Retinal fundus photograph. FOV: 45 degrees:
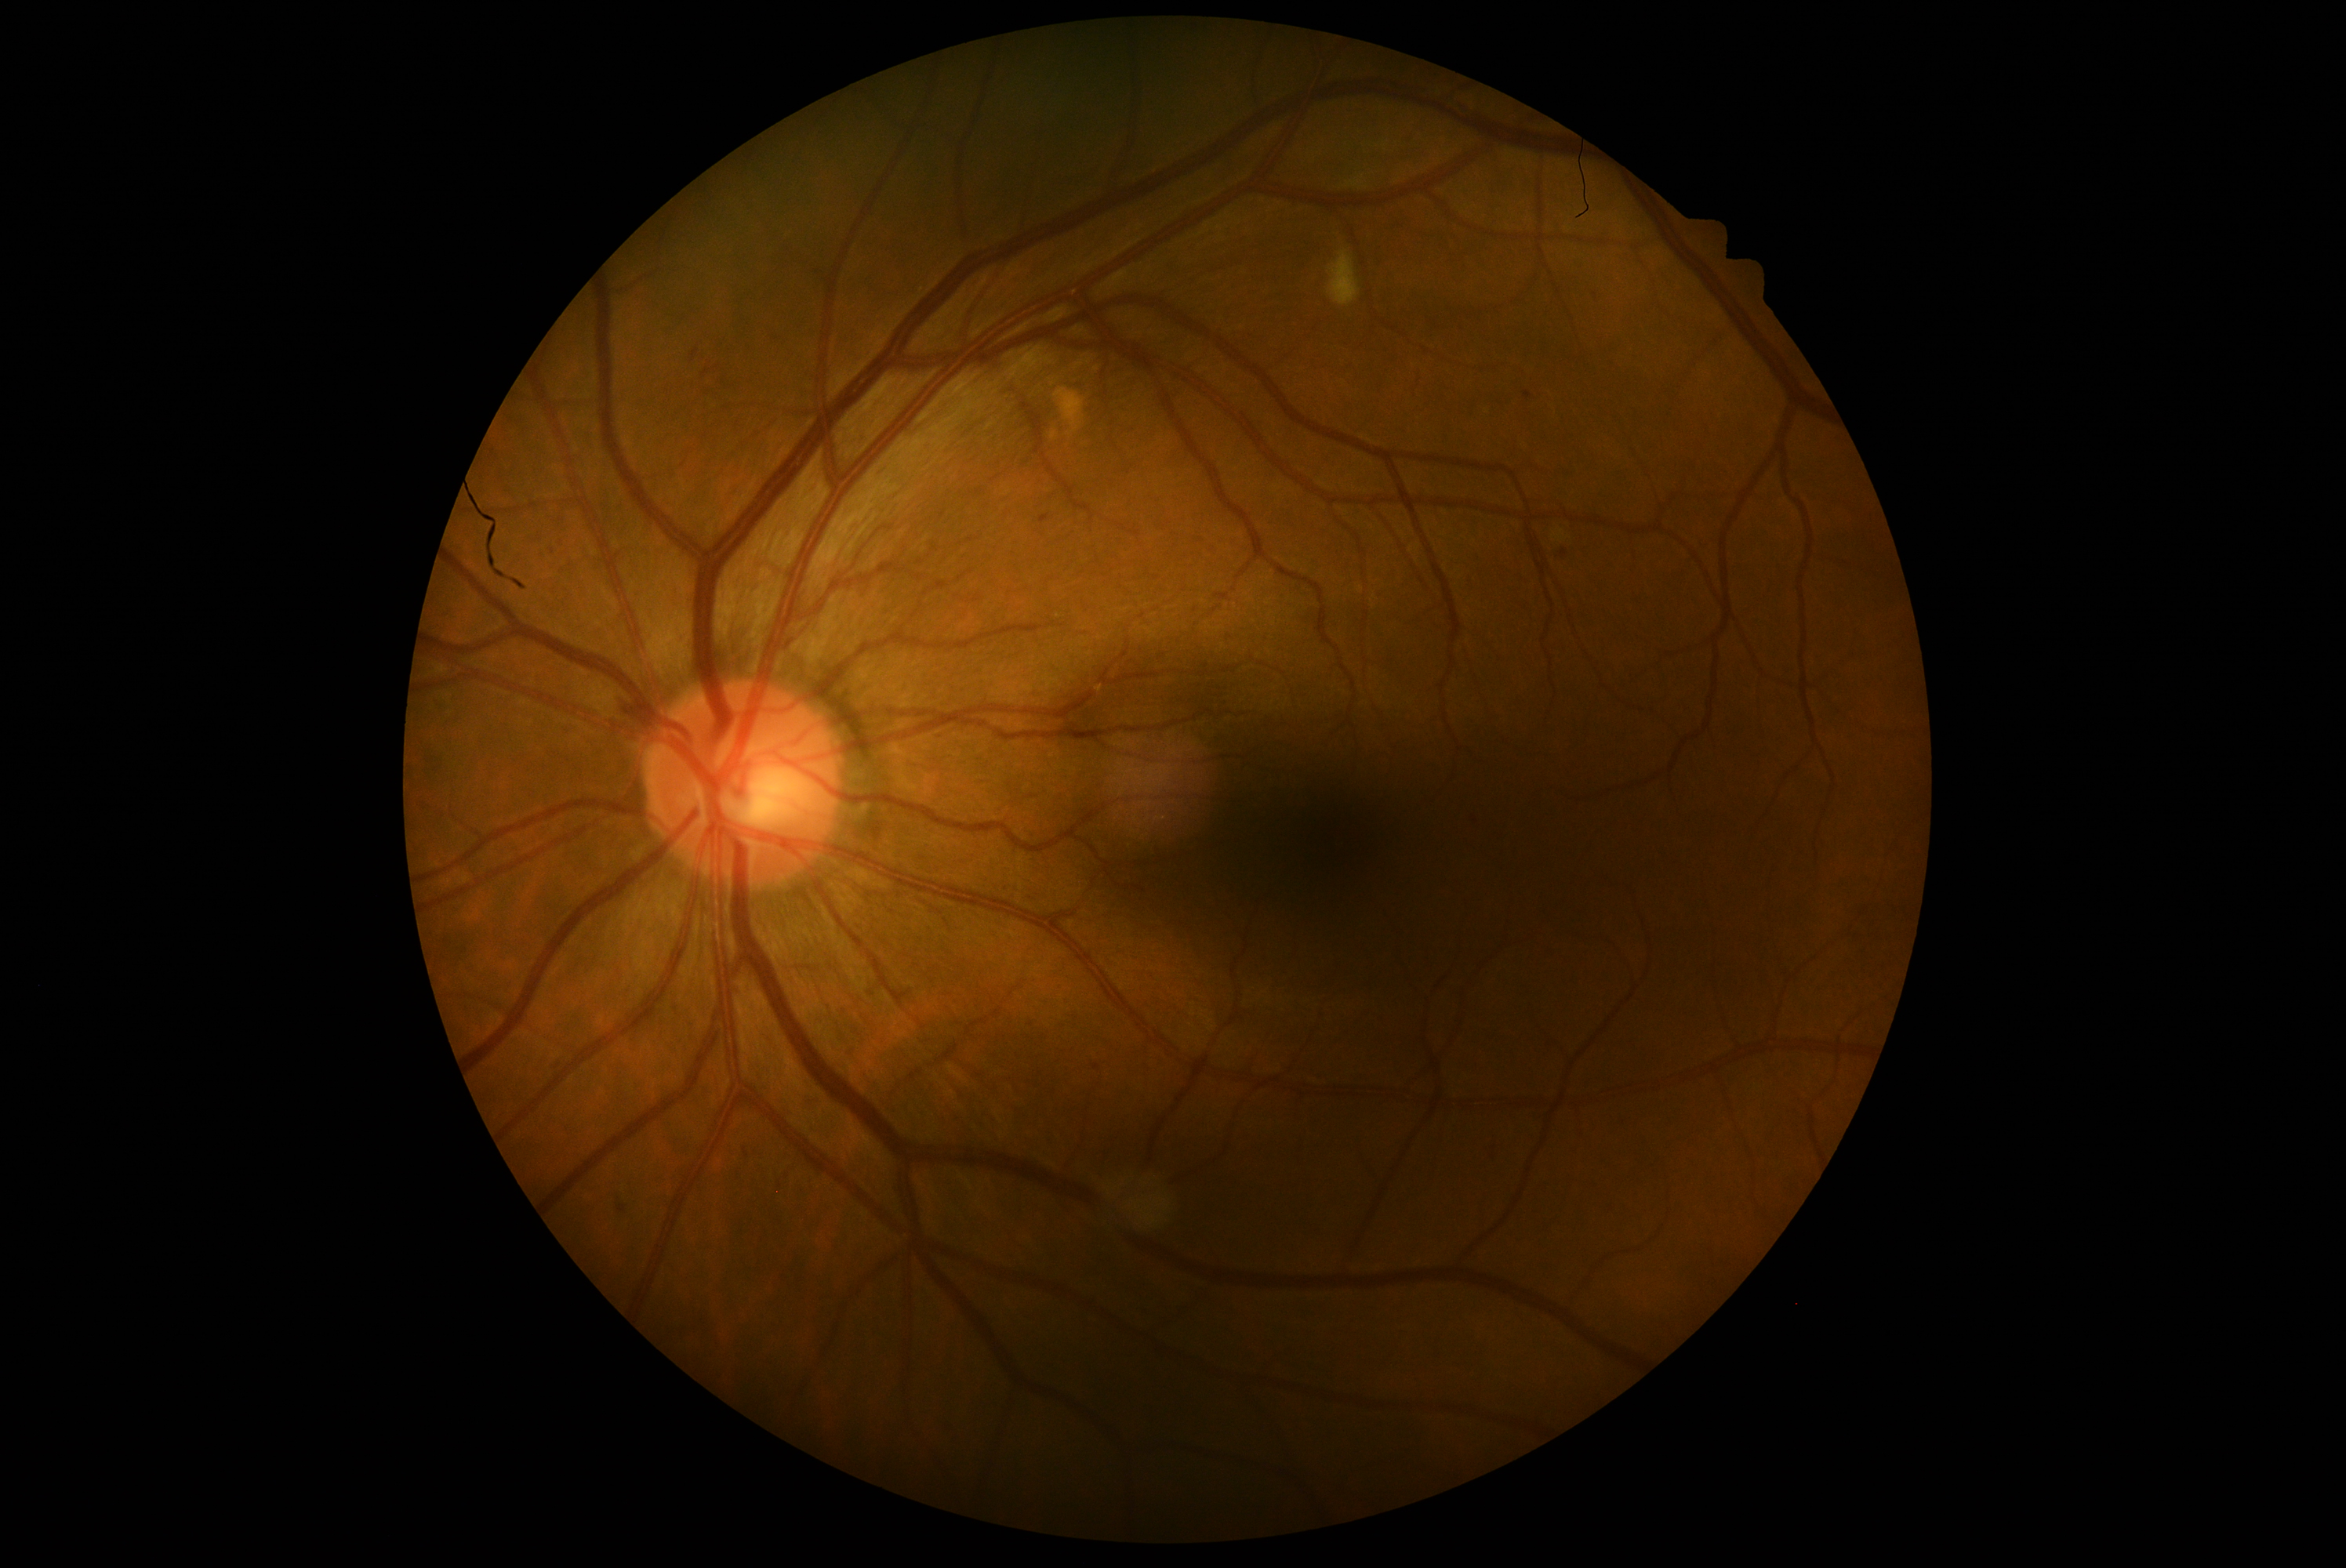
DR stage: grade 2.